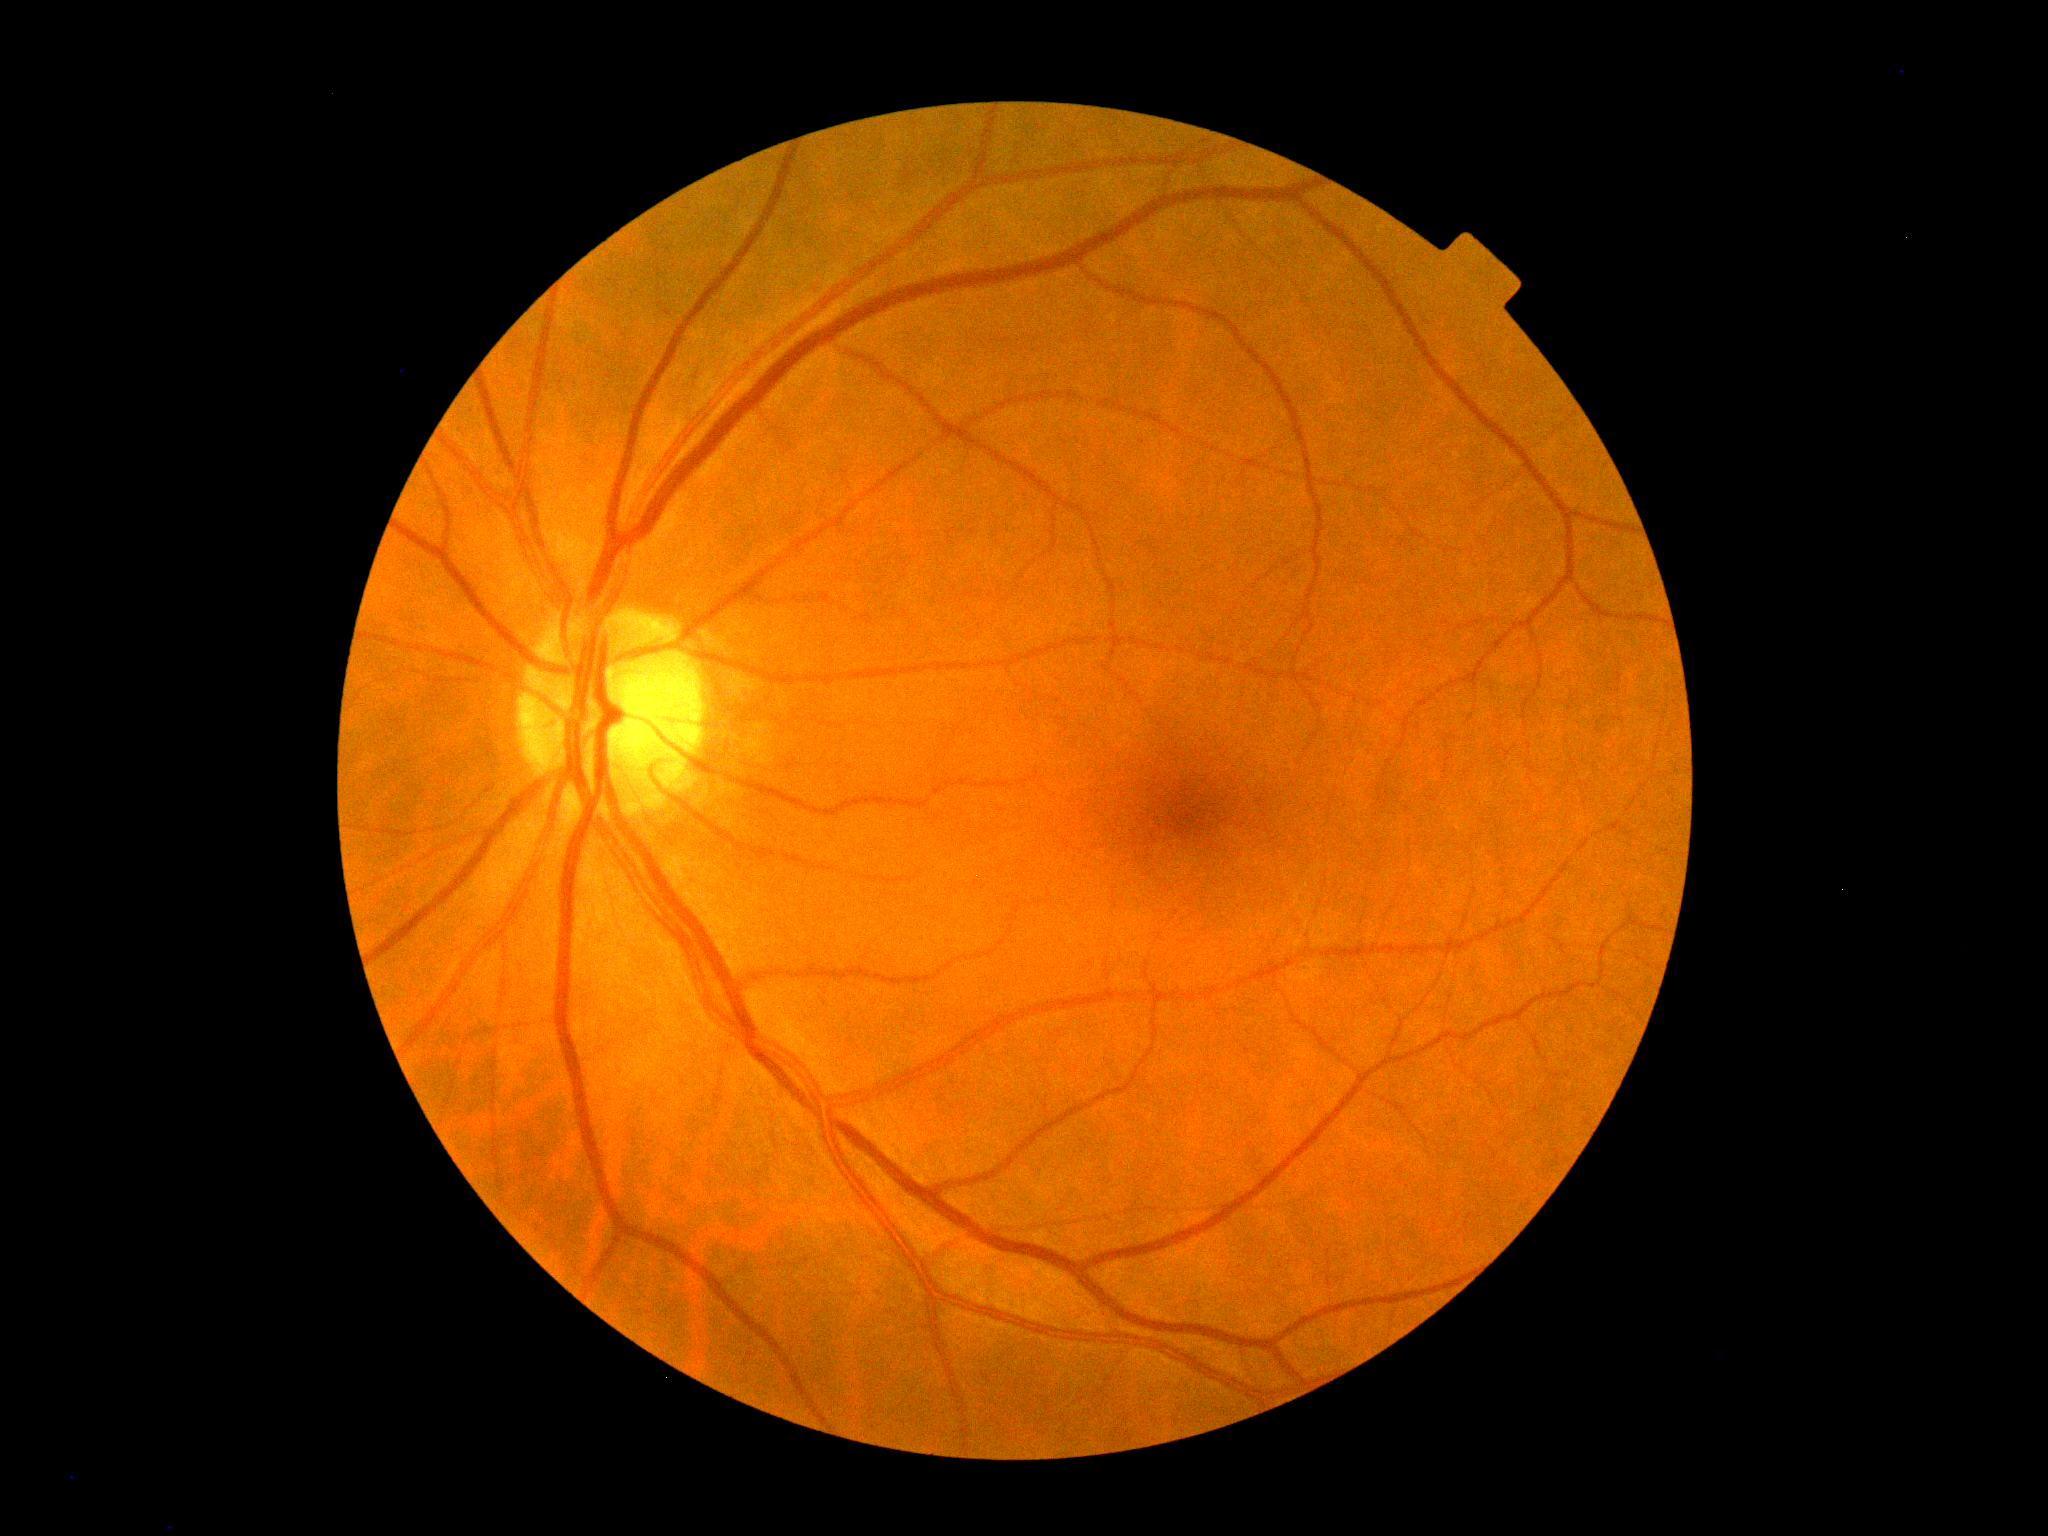 diabetic retinopathy = grade 0 (no apparent retinopathy)